Modified Davis grading:
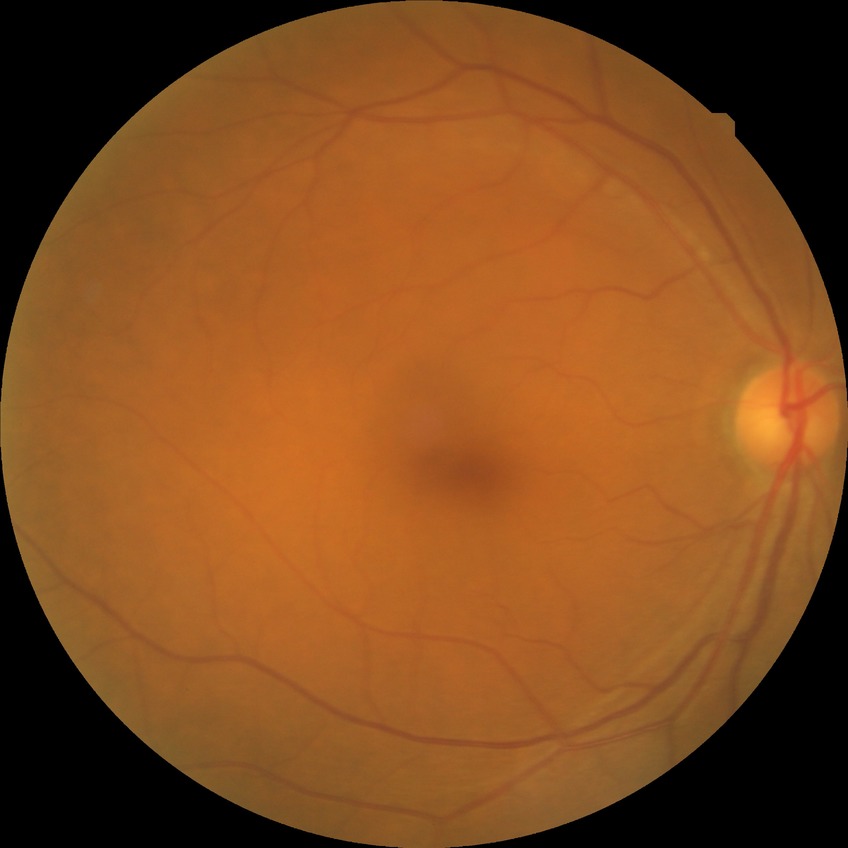

diabetic retinopathy (DR): no diabetic retinopathy (NDR).